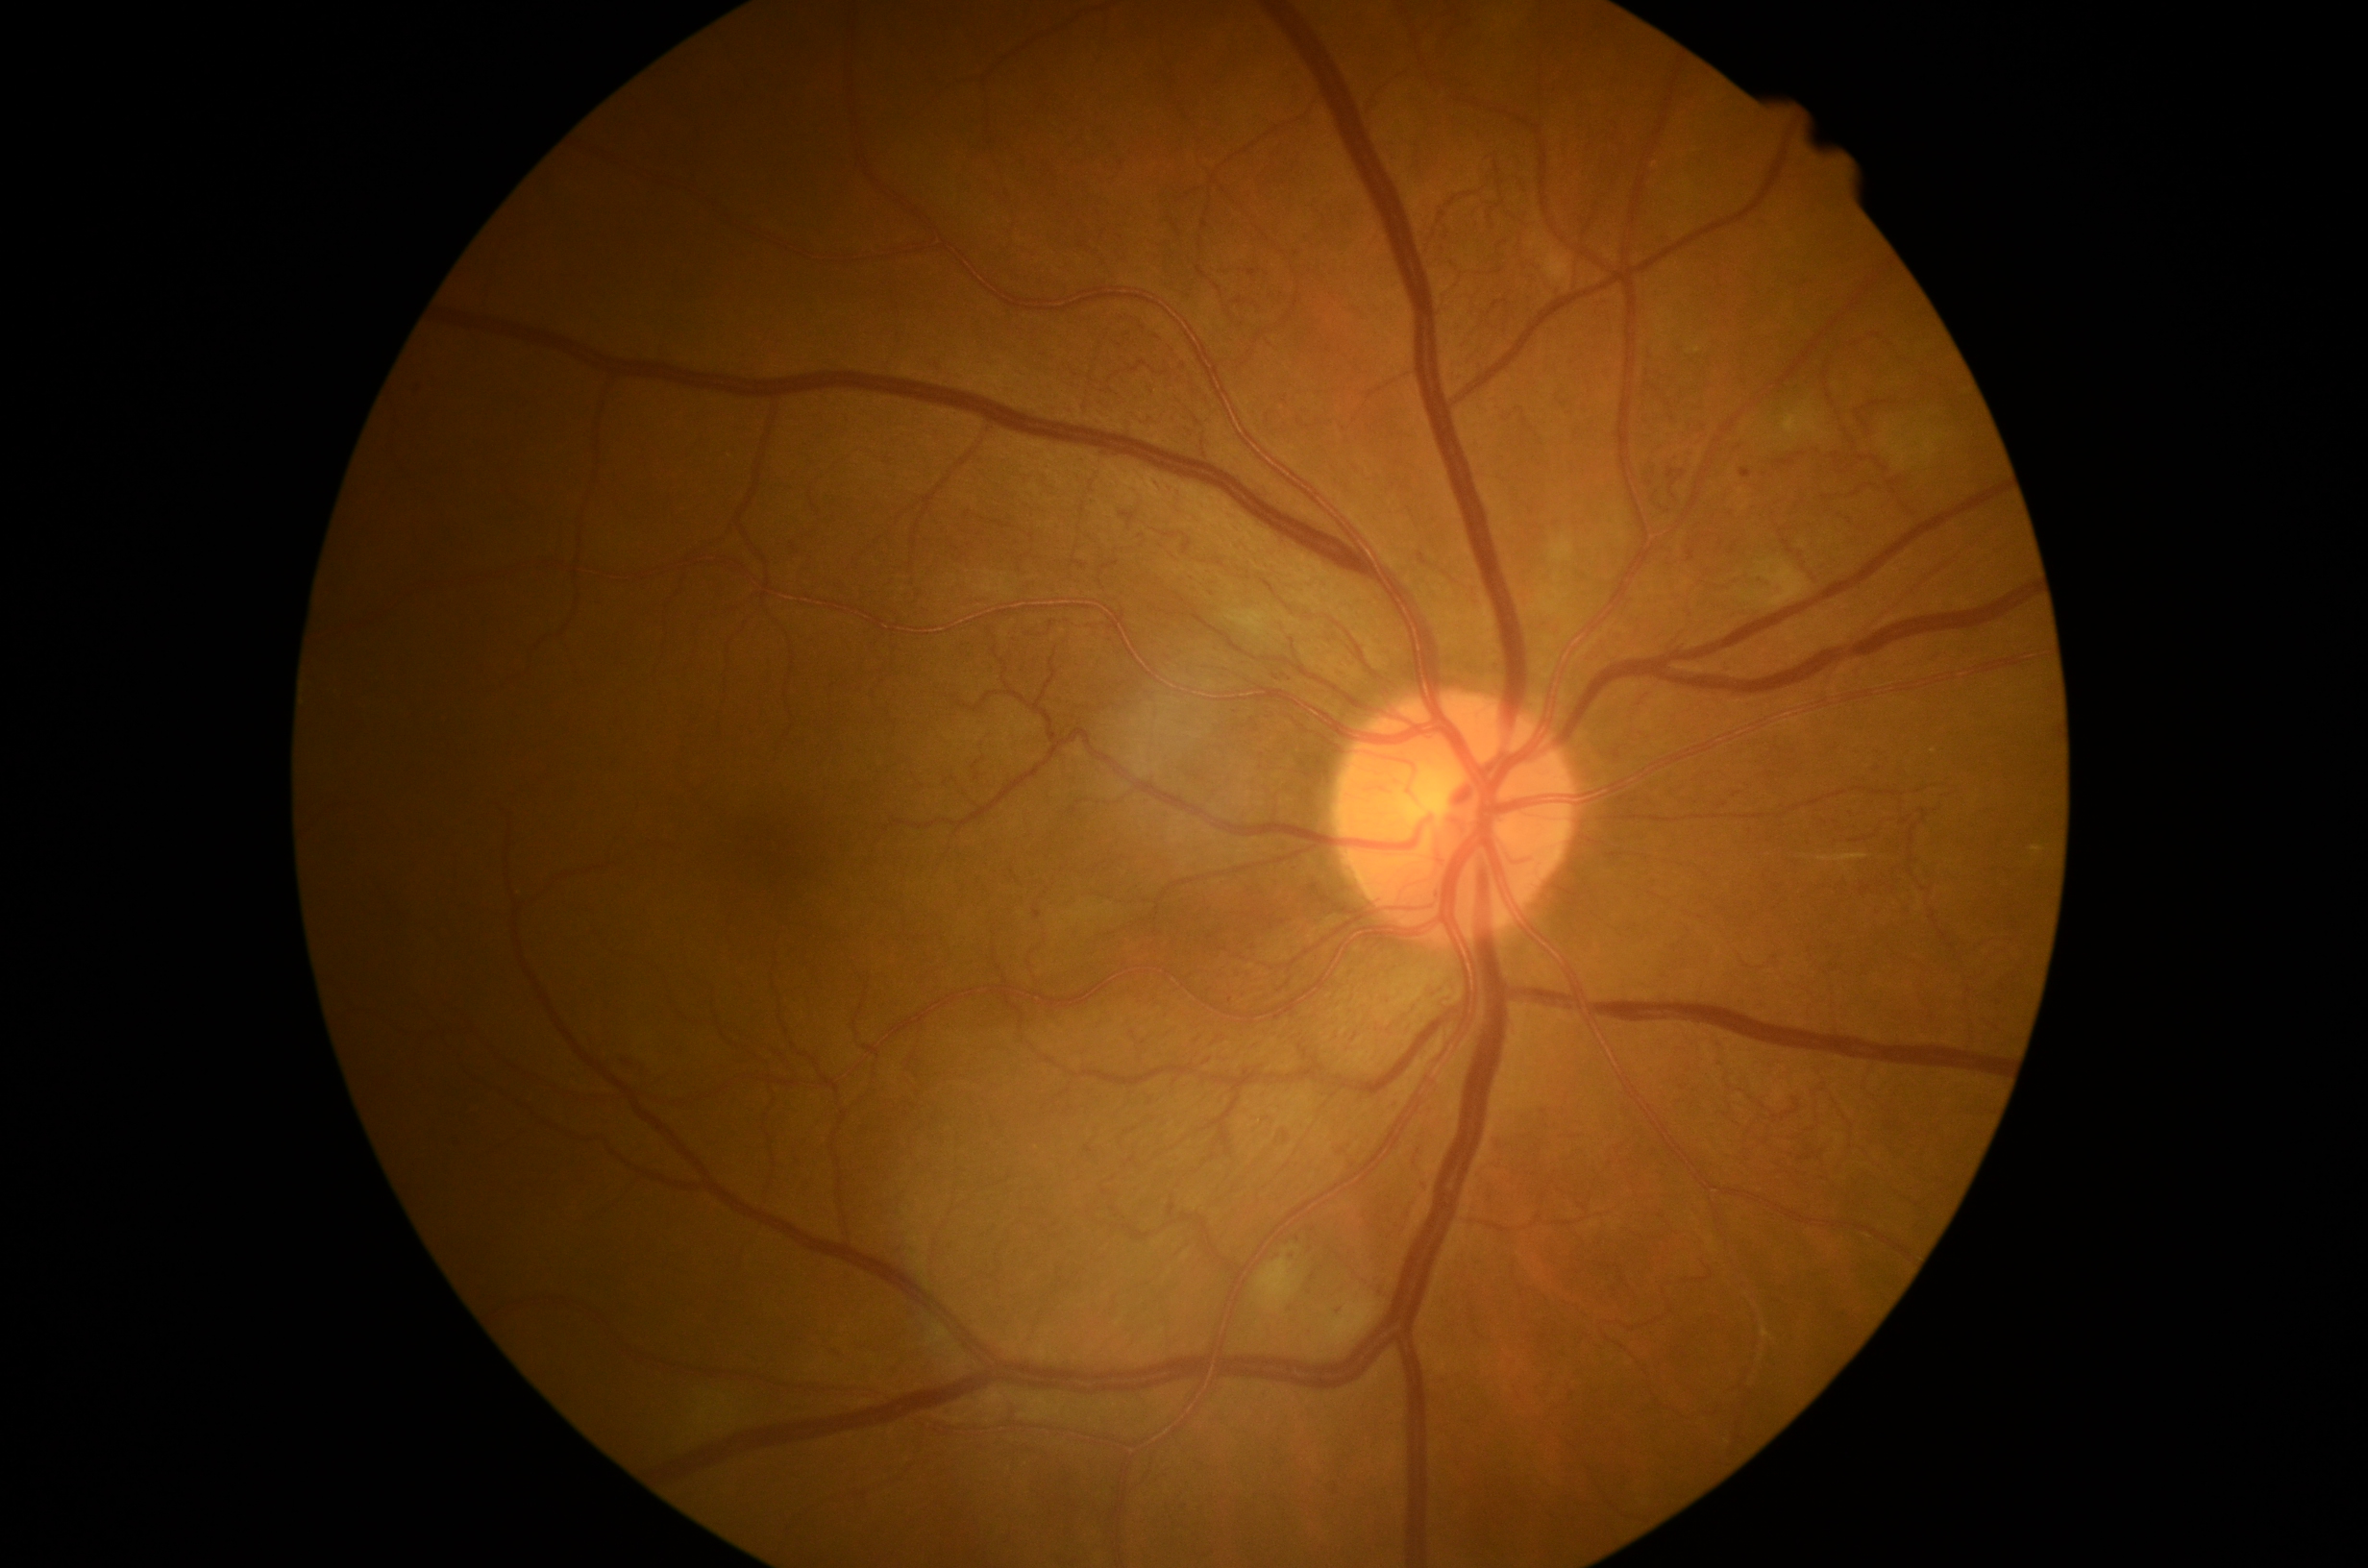

  dr_category: non-proliferative diabetic retinopathy
  dr_grade: 3/4